Pediatric retinal photograph (wide-field). Phoenix ICON, 100° FOV:
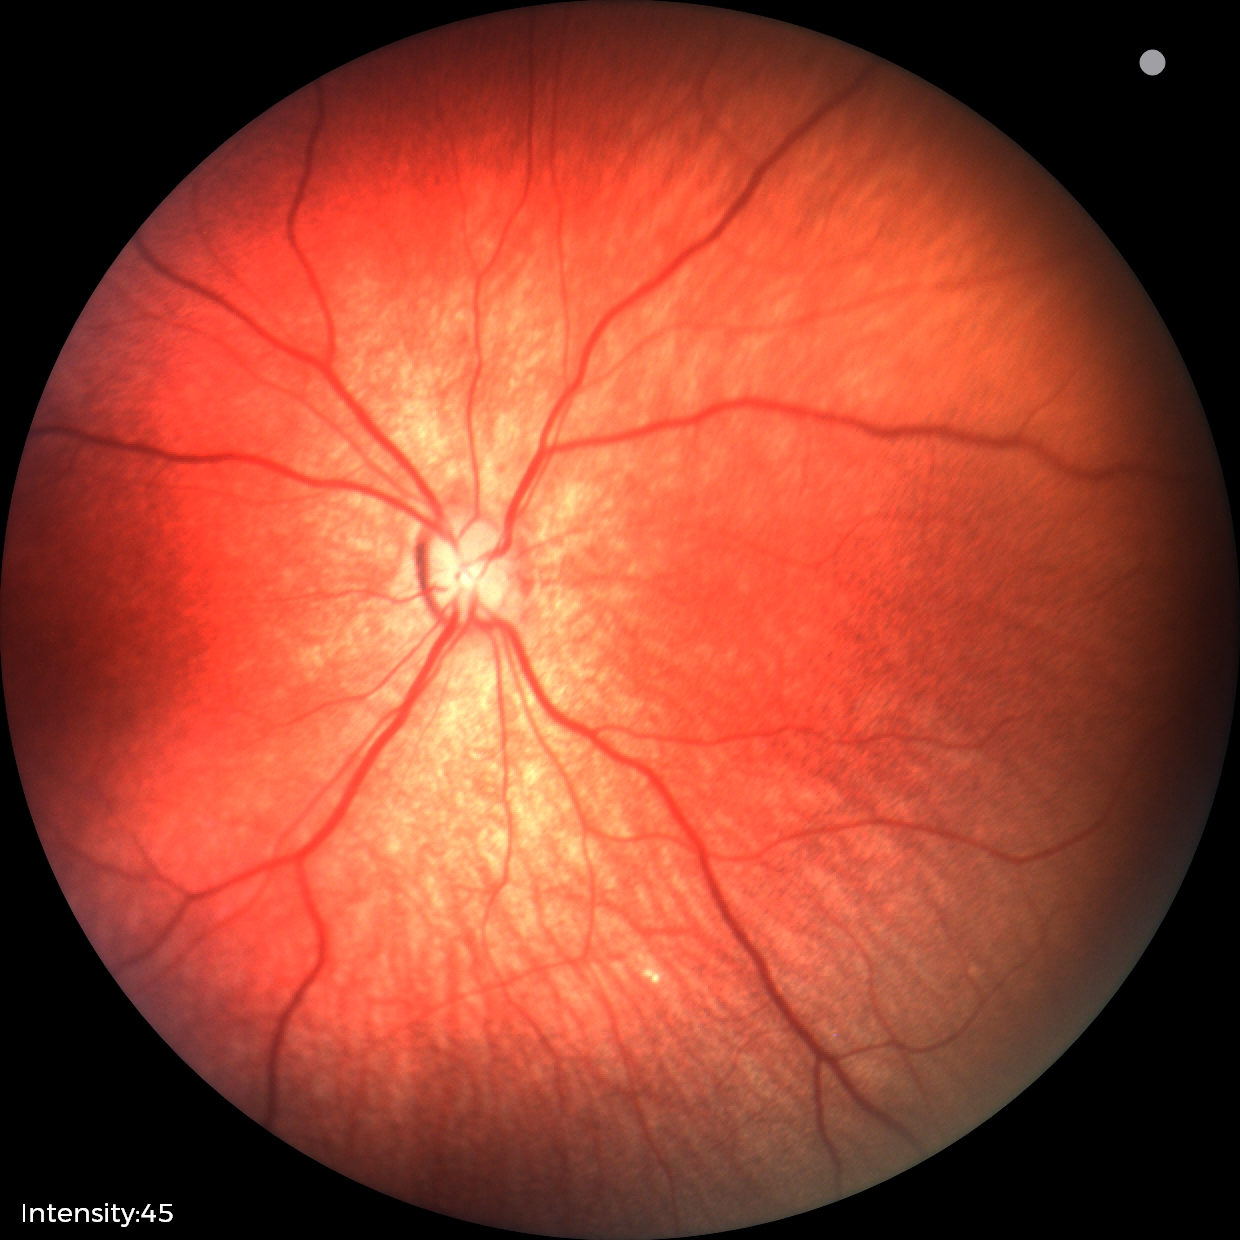

Impression: physiological appearance with no retinal pathology.